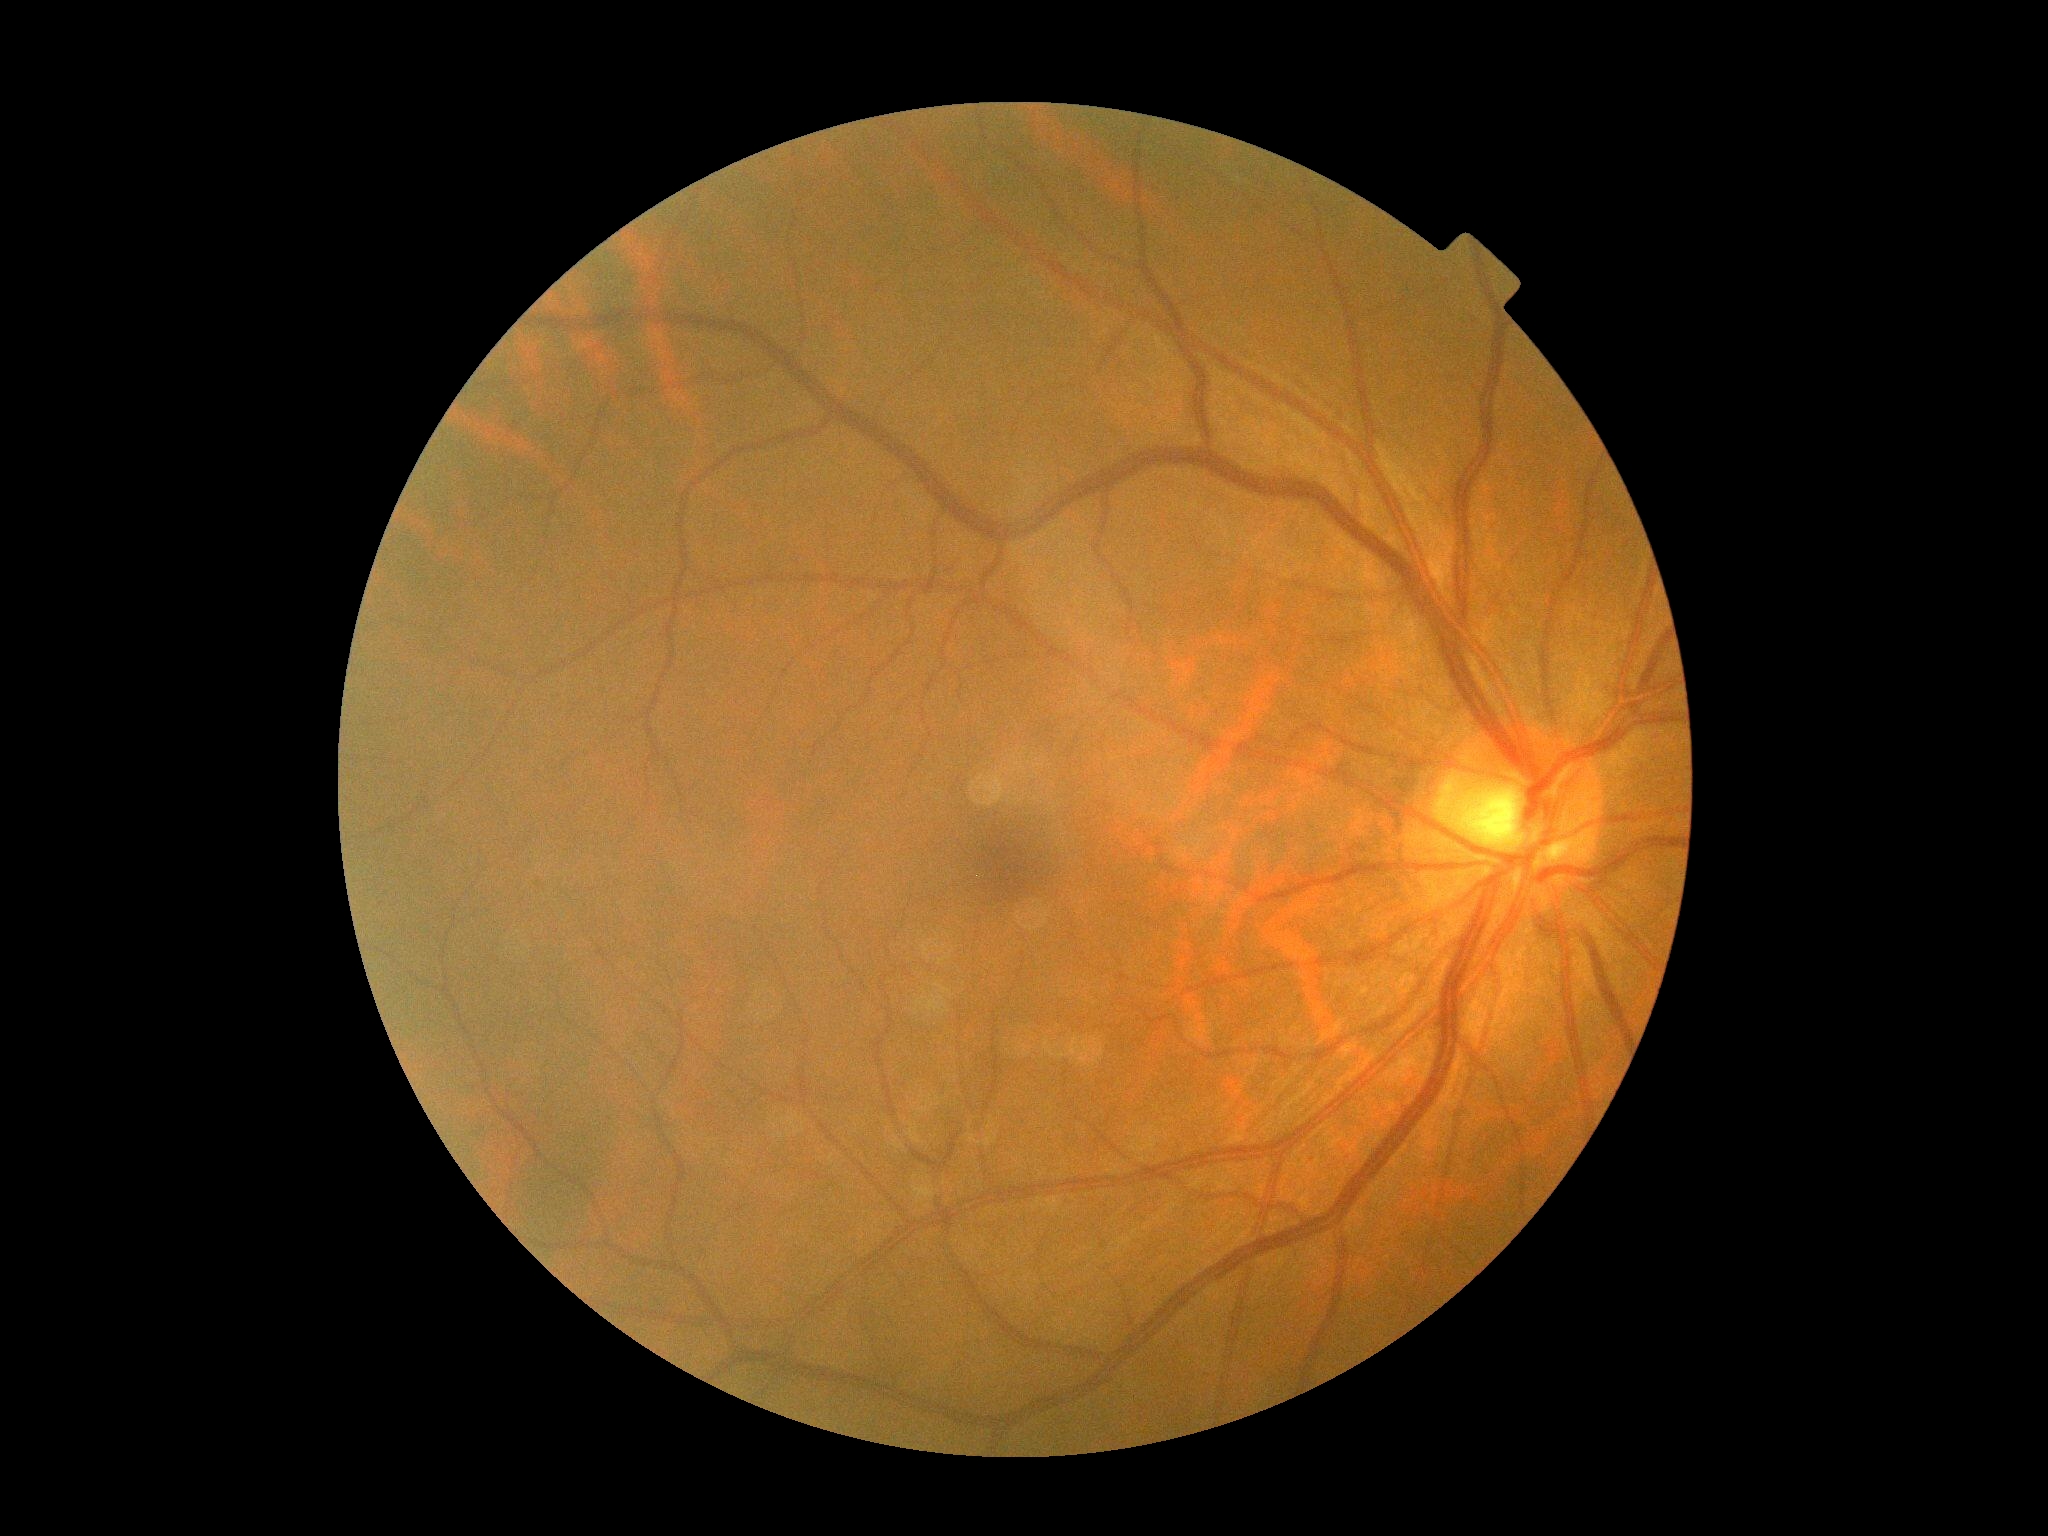 No diabetic retinal disease findings. Retinopathy grade is no apparent retinopathy (0).